Posterior pole field covering the optic disc and macula
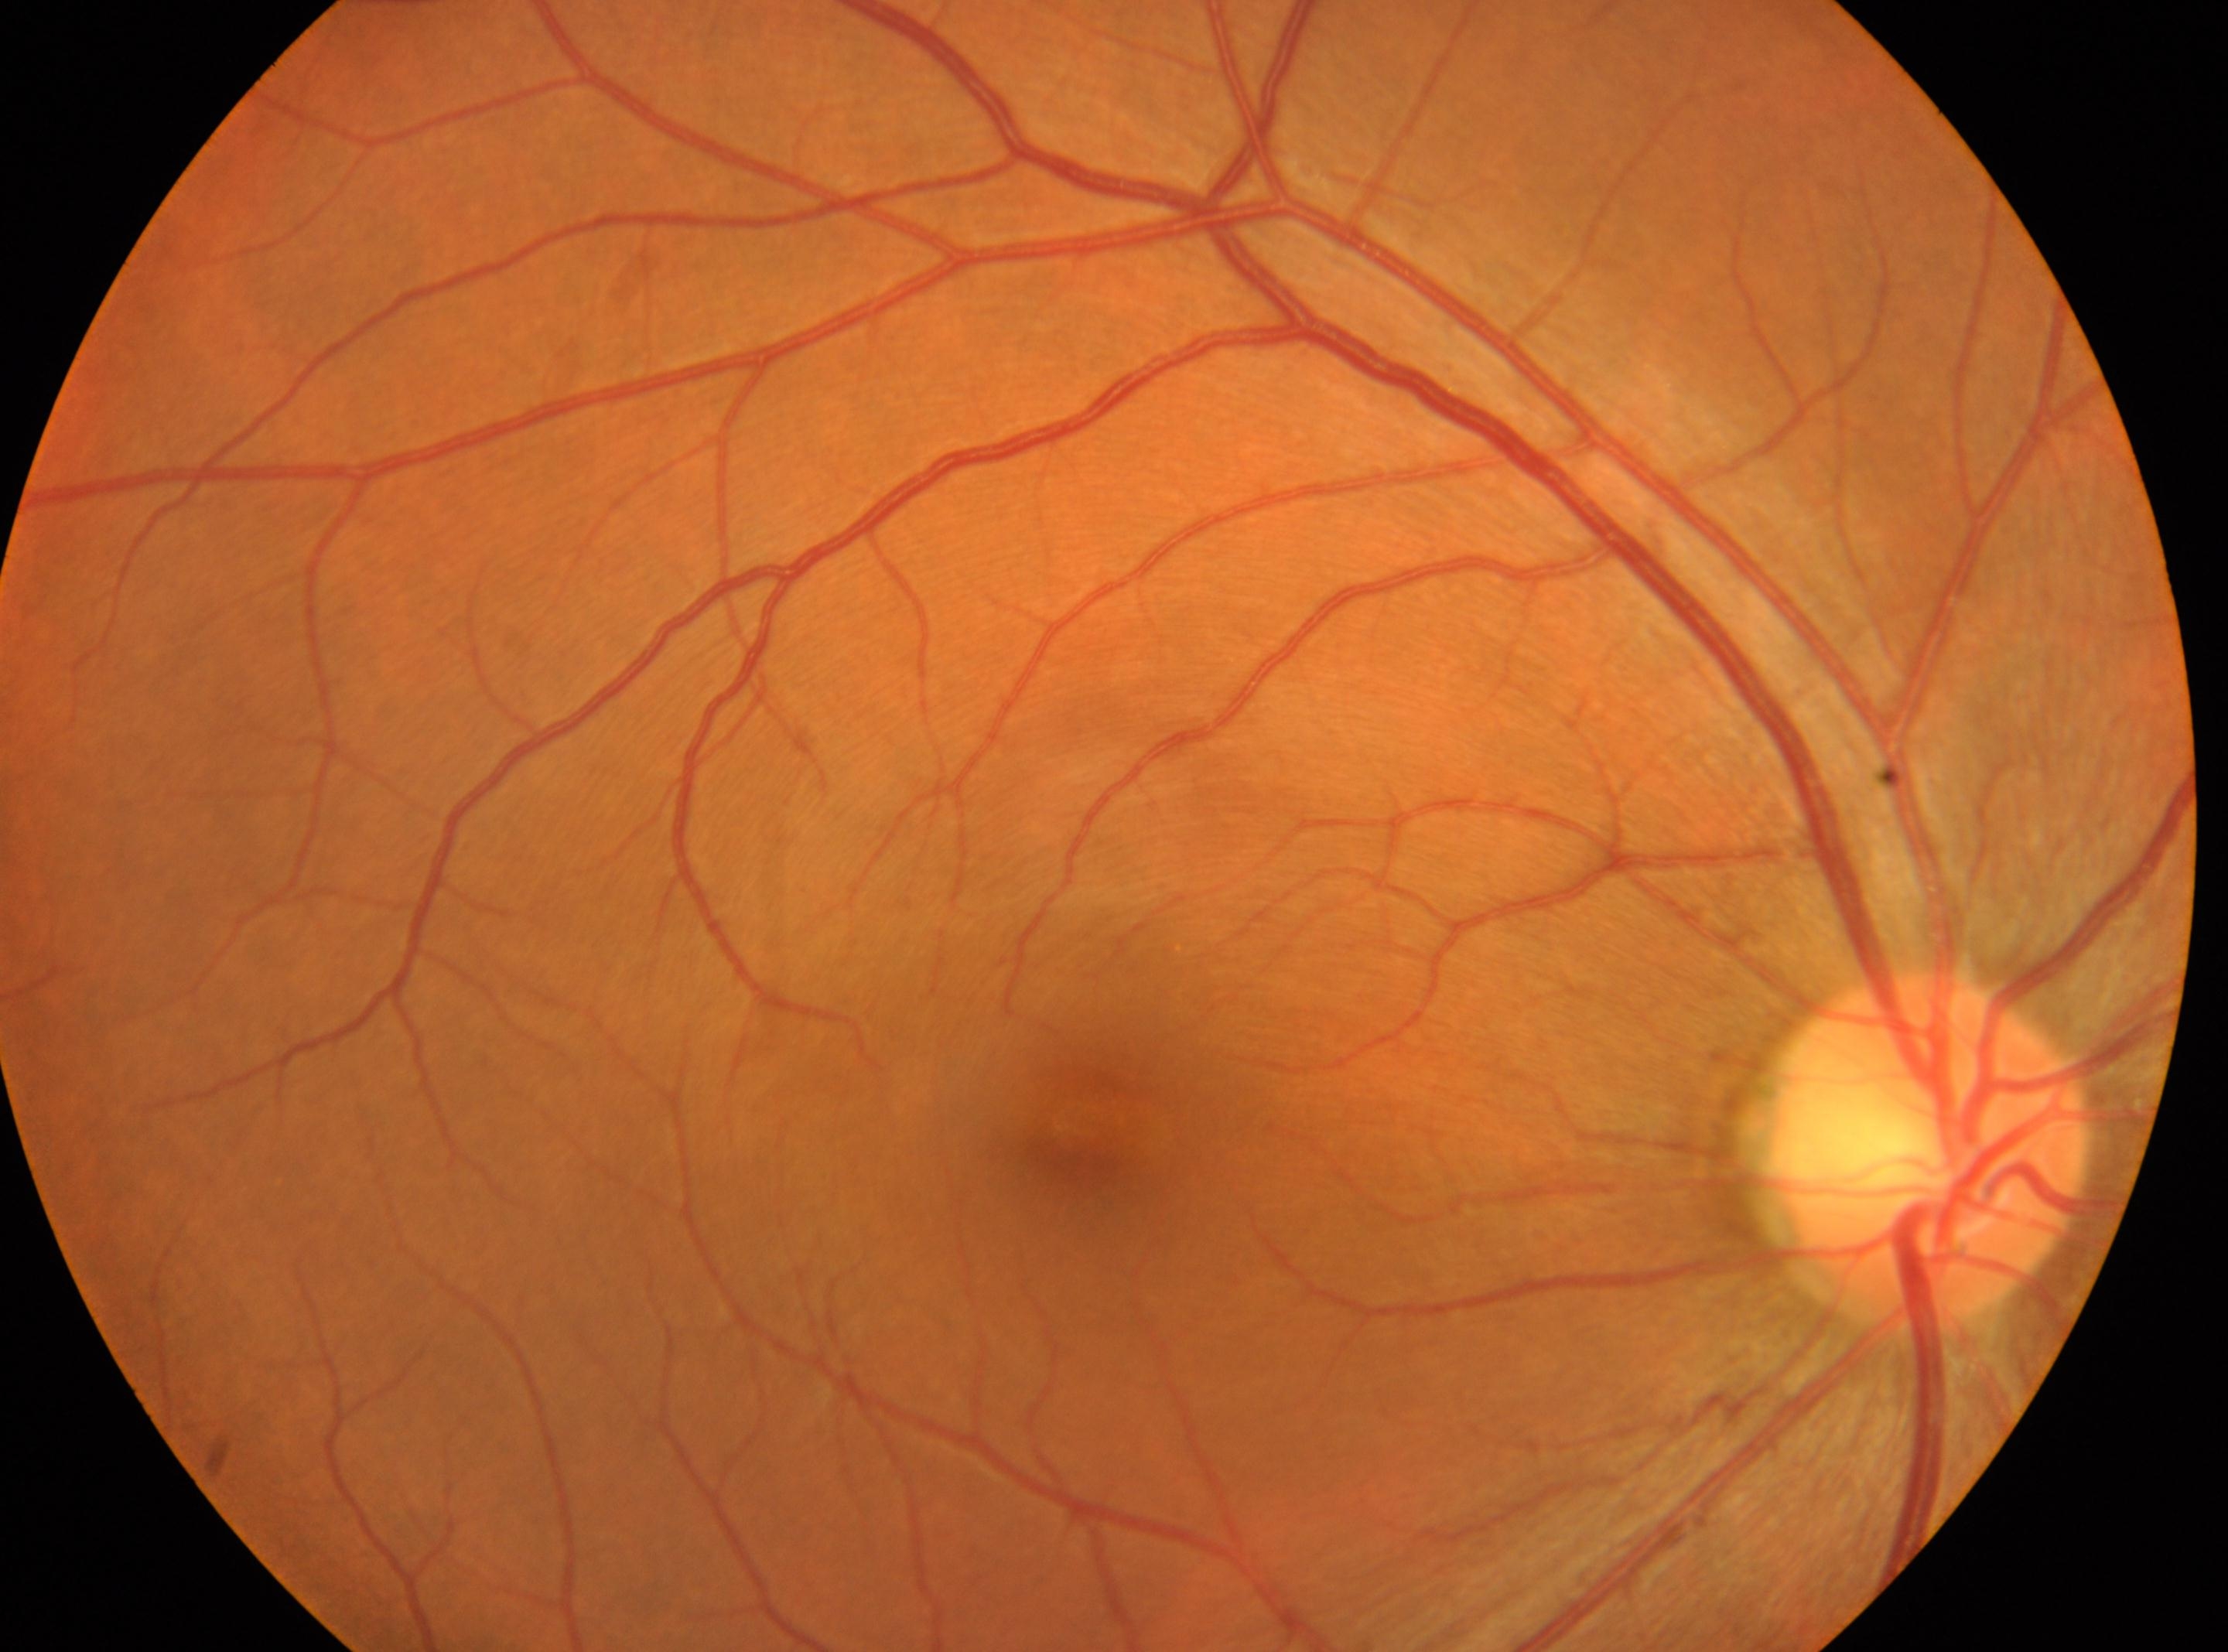 DR severity is no apparent diabetic retinopathy (grade 0). No DR findings. ONH: (x=1930, y=1149). This is the right eye. The fovea is at (x=1083, y=1142).